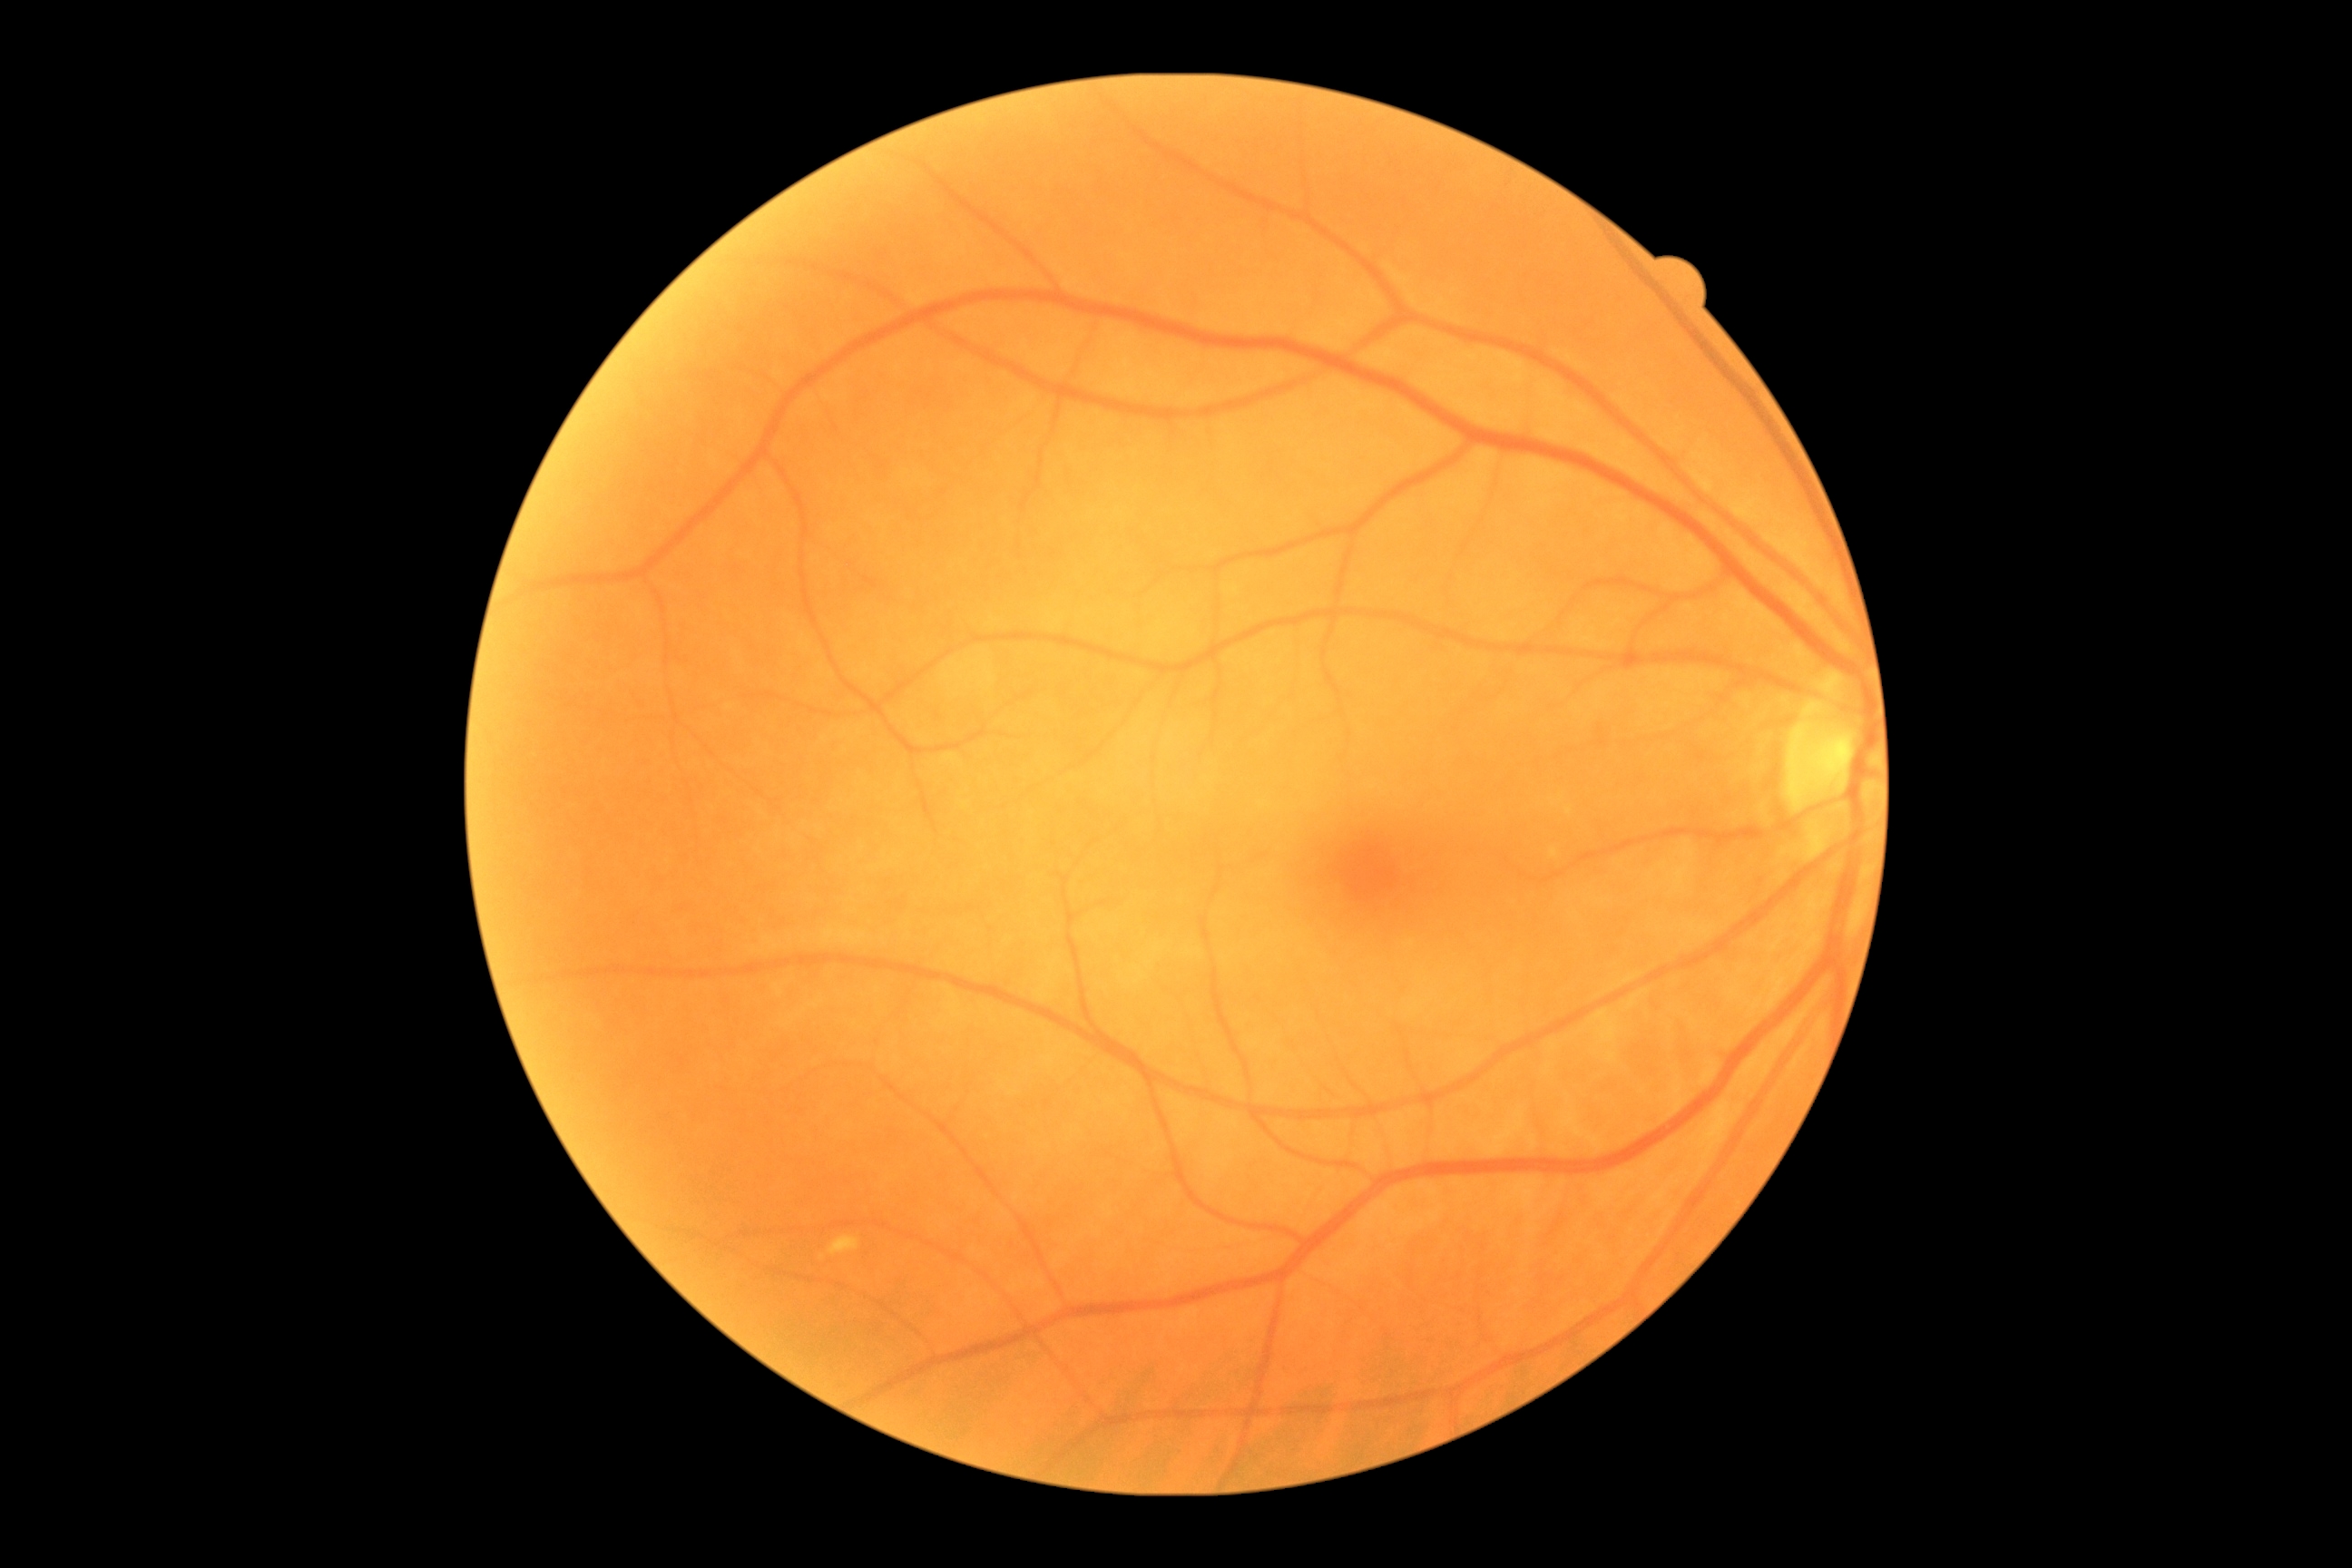 DR severity is grade 2 (moderate NPDR) — more than just microaneurysms but less than severe NPDR.